45° field of view
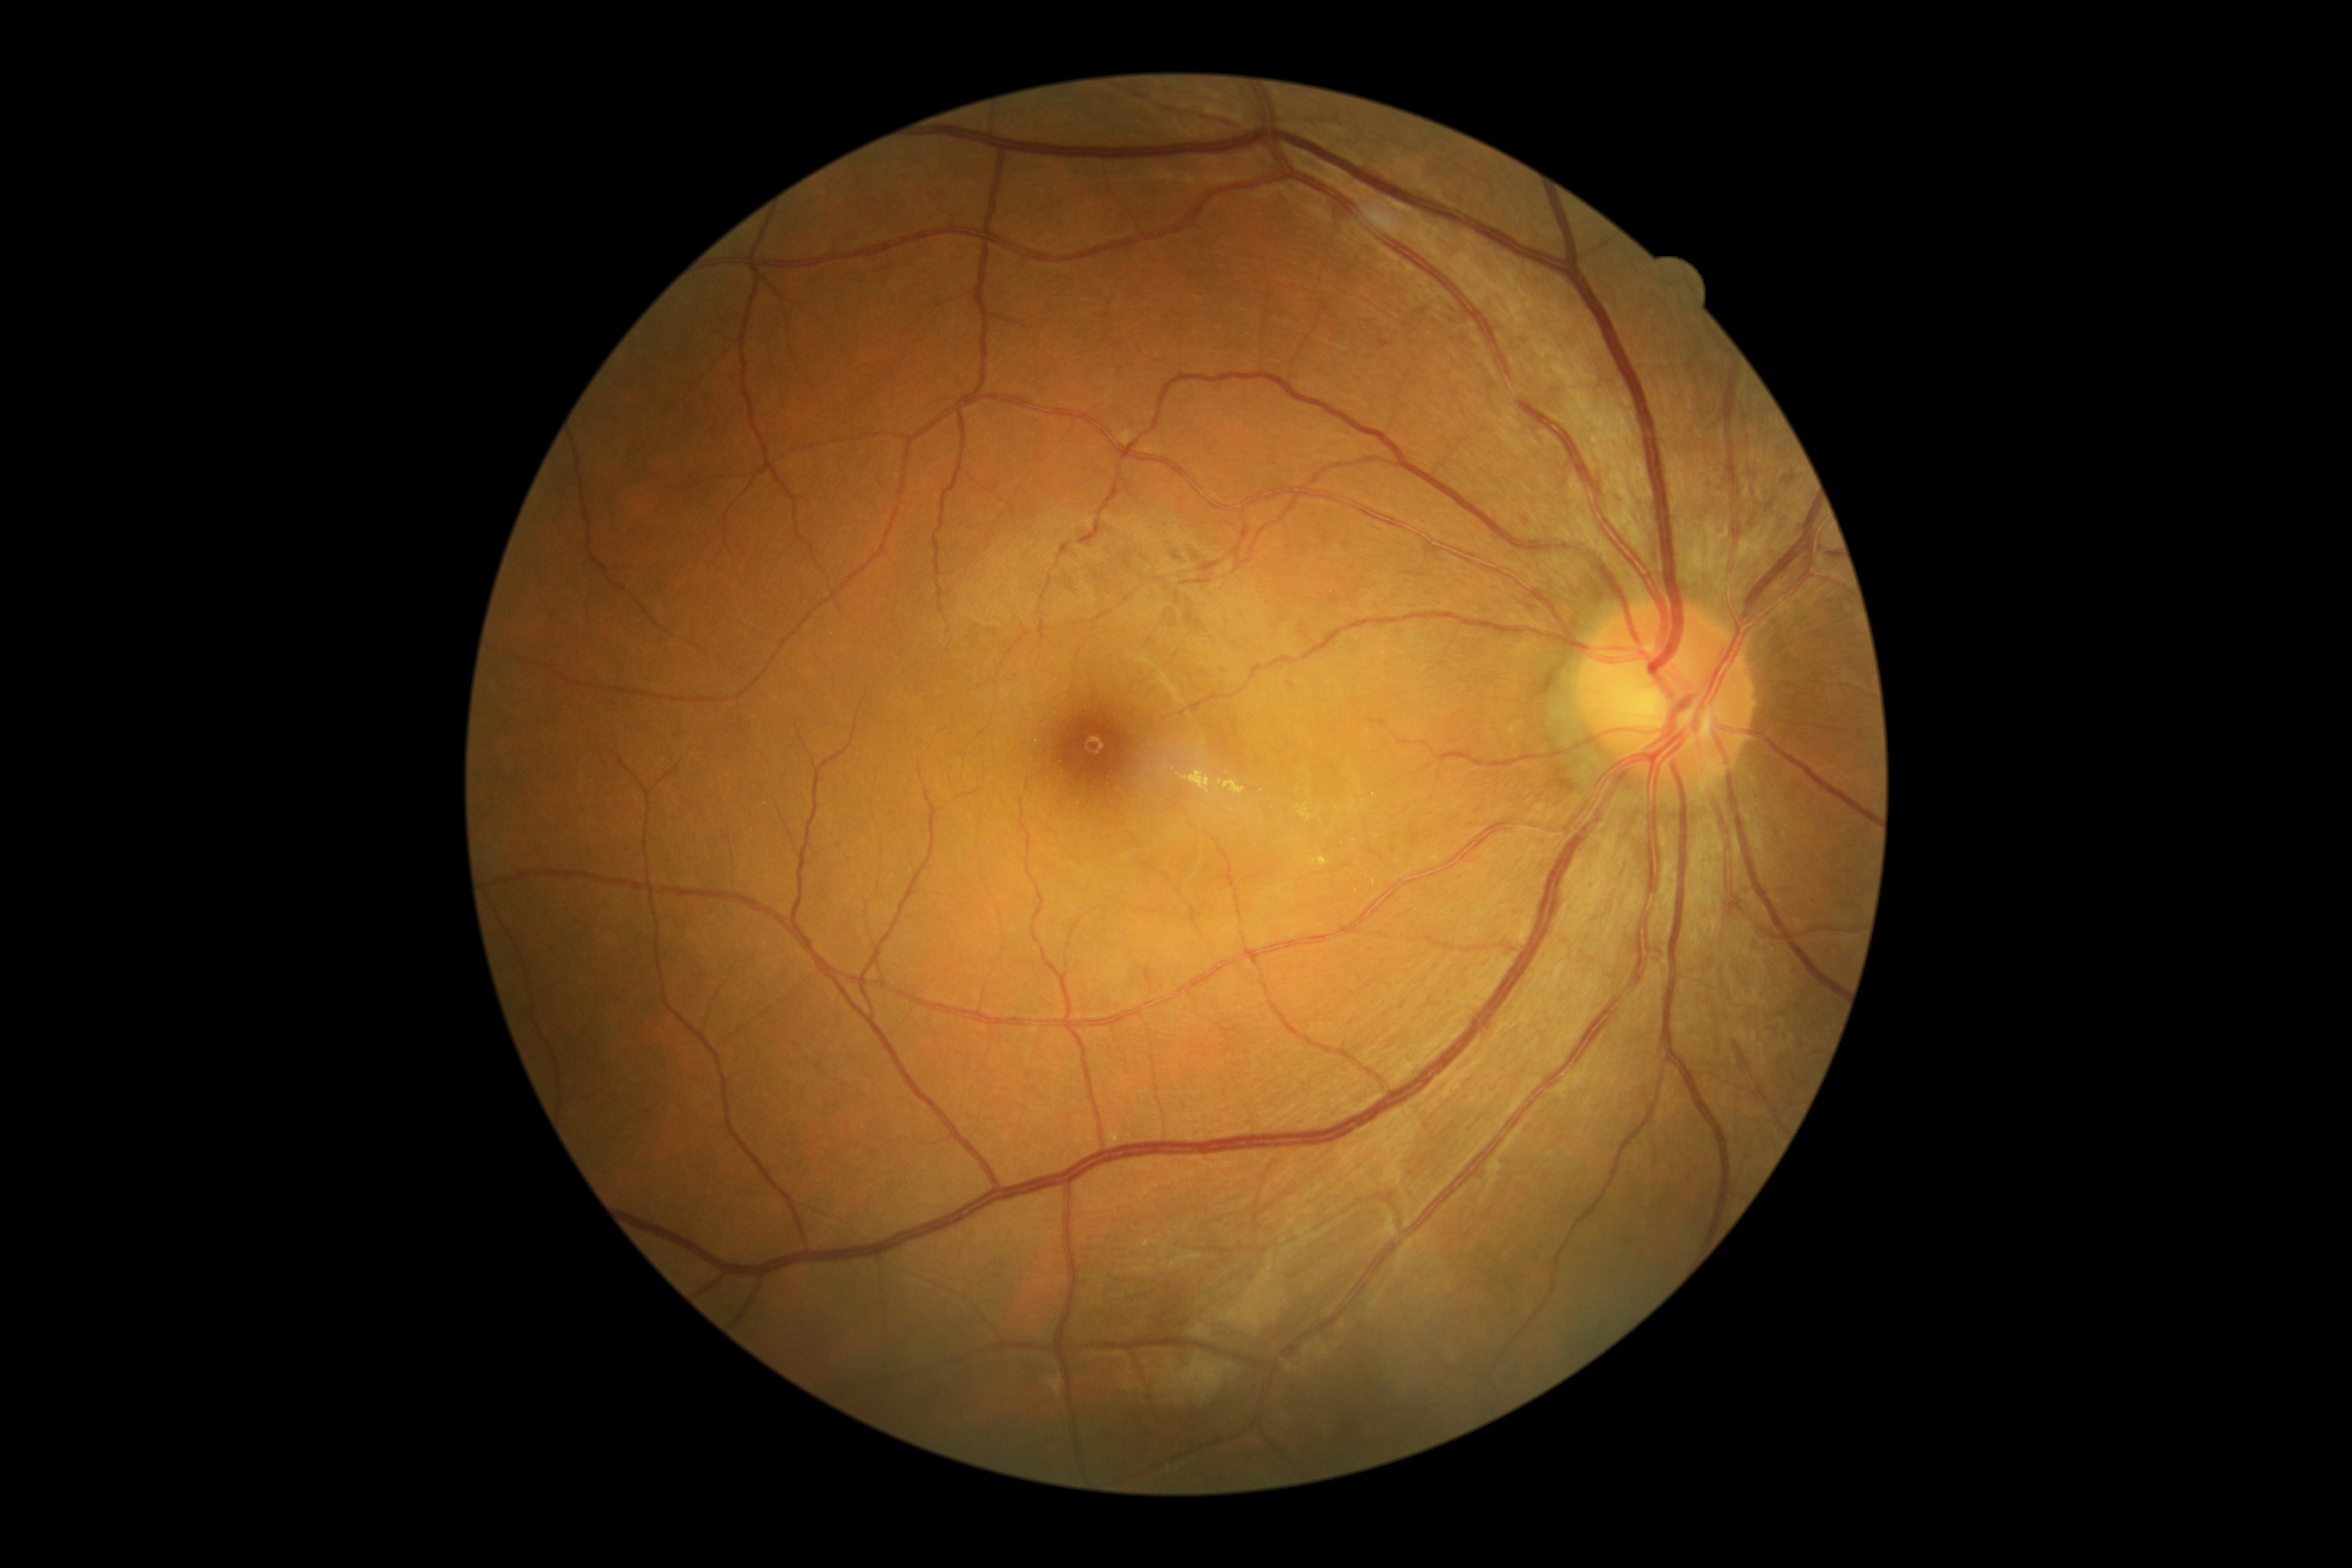 DR class@non-proliferative diabetic retinopathy; DR grade@2 — more than just microaneurysms but less than severe NPDR.